Acquired on the Phoenix ICON; wide-field fundus photograph of an infant; 1240 by 1240 pixels — 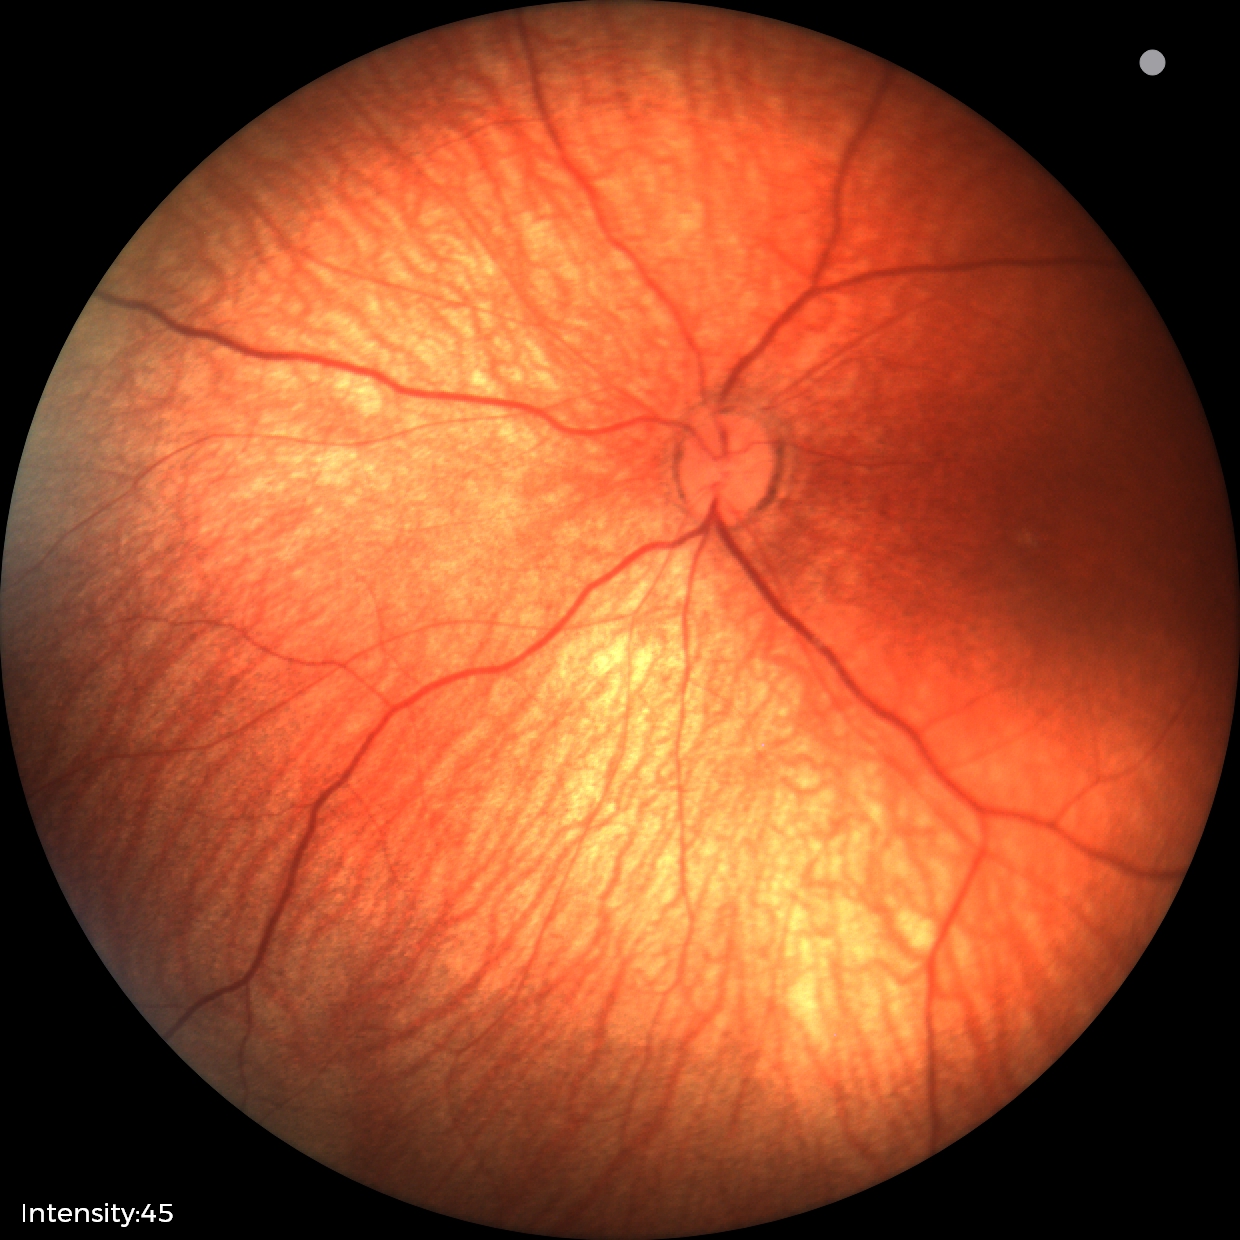

Examination with physiological retinal findings.